NIDEK AFC-230; nonmydriatic fundus photograph: 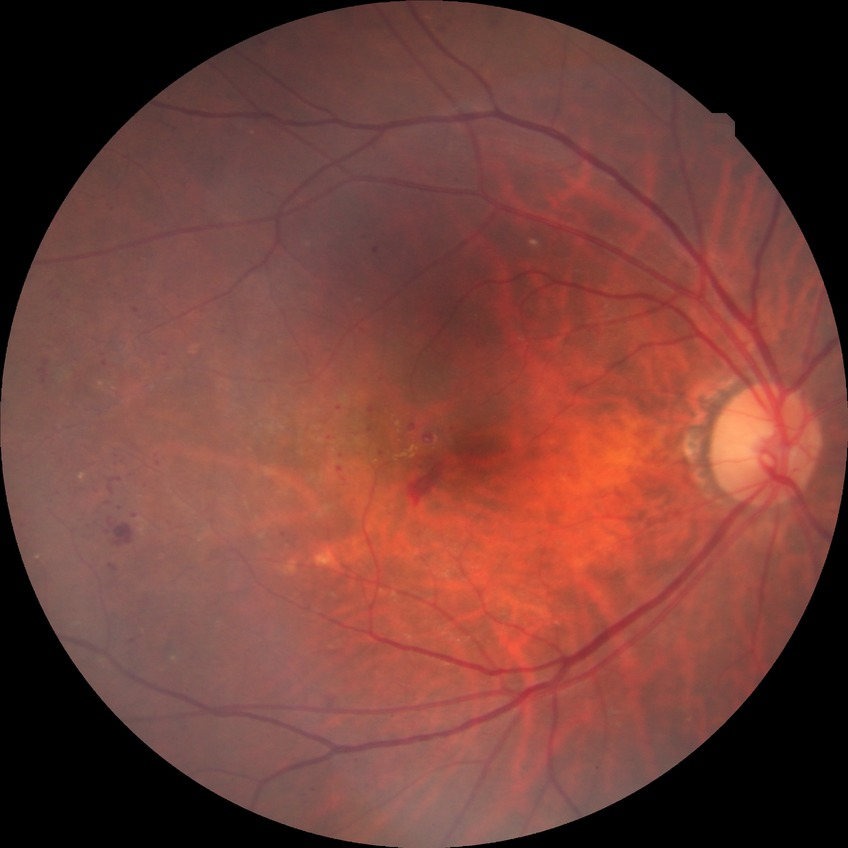 DR stage is PDR.